45° FOV · 1536 x 1152 pixels
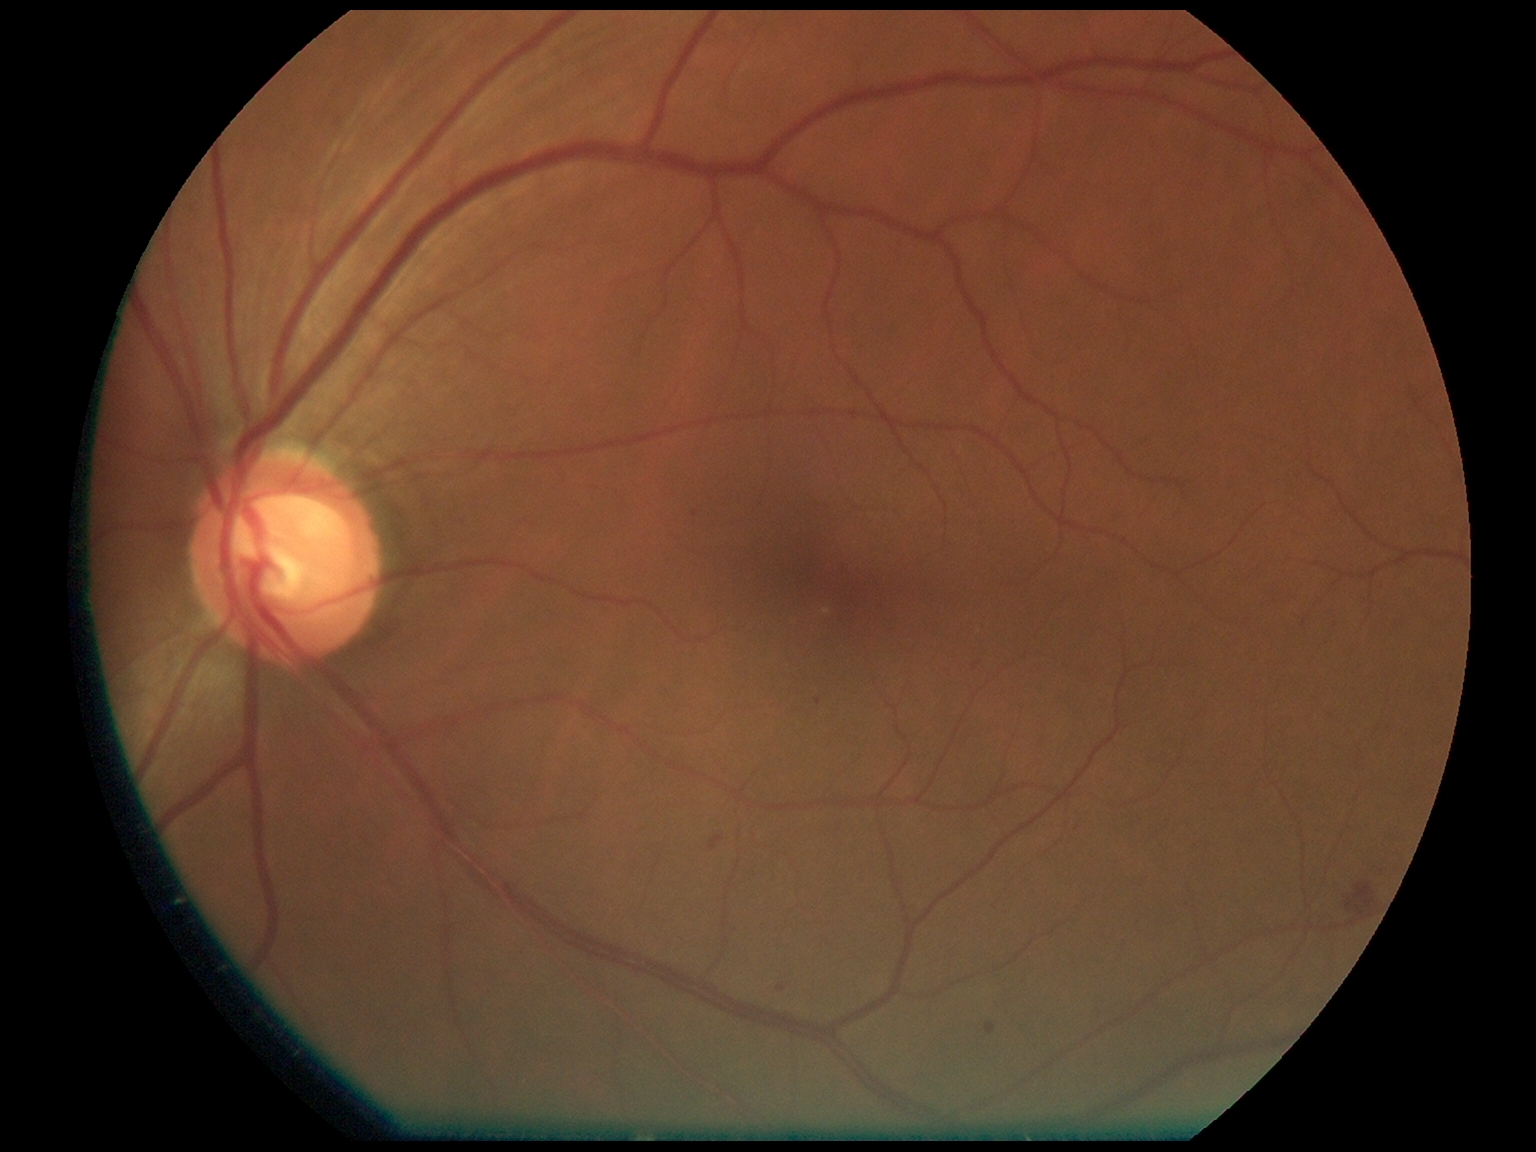 DR stage = grade 2 — more than just microaneurysms but less than severe NPDR, DR class = non-proliferative diabetic retinopathy.